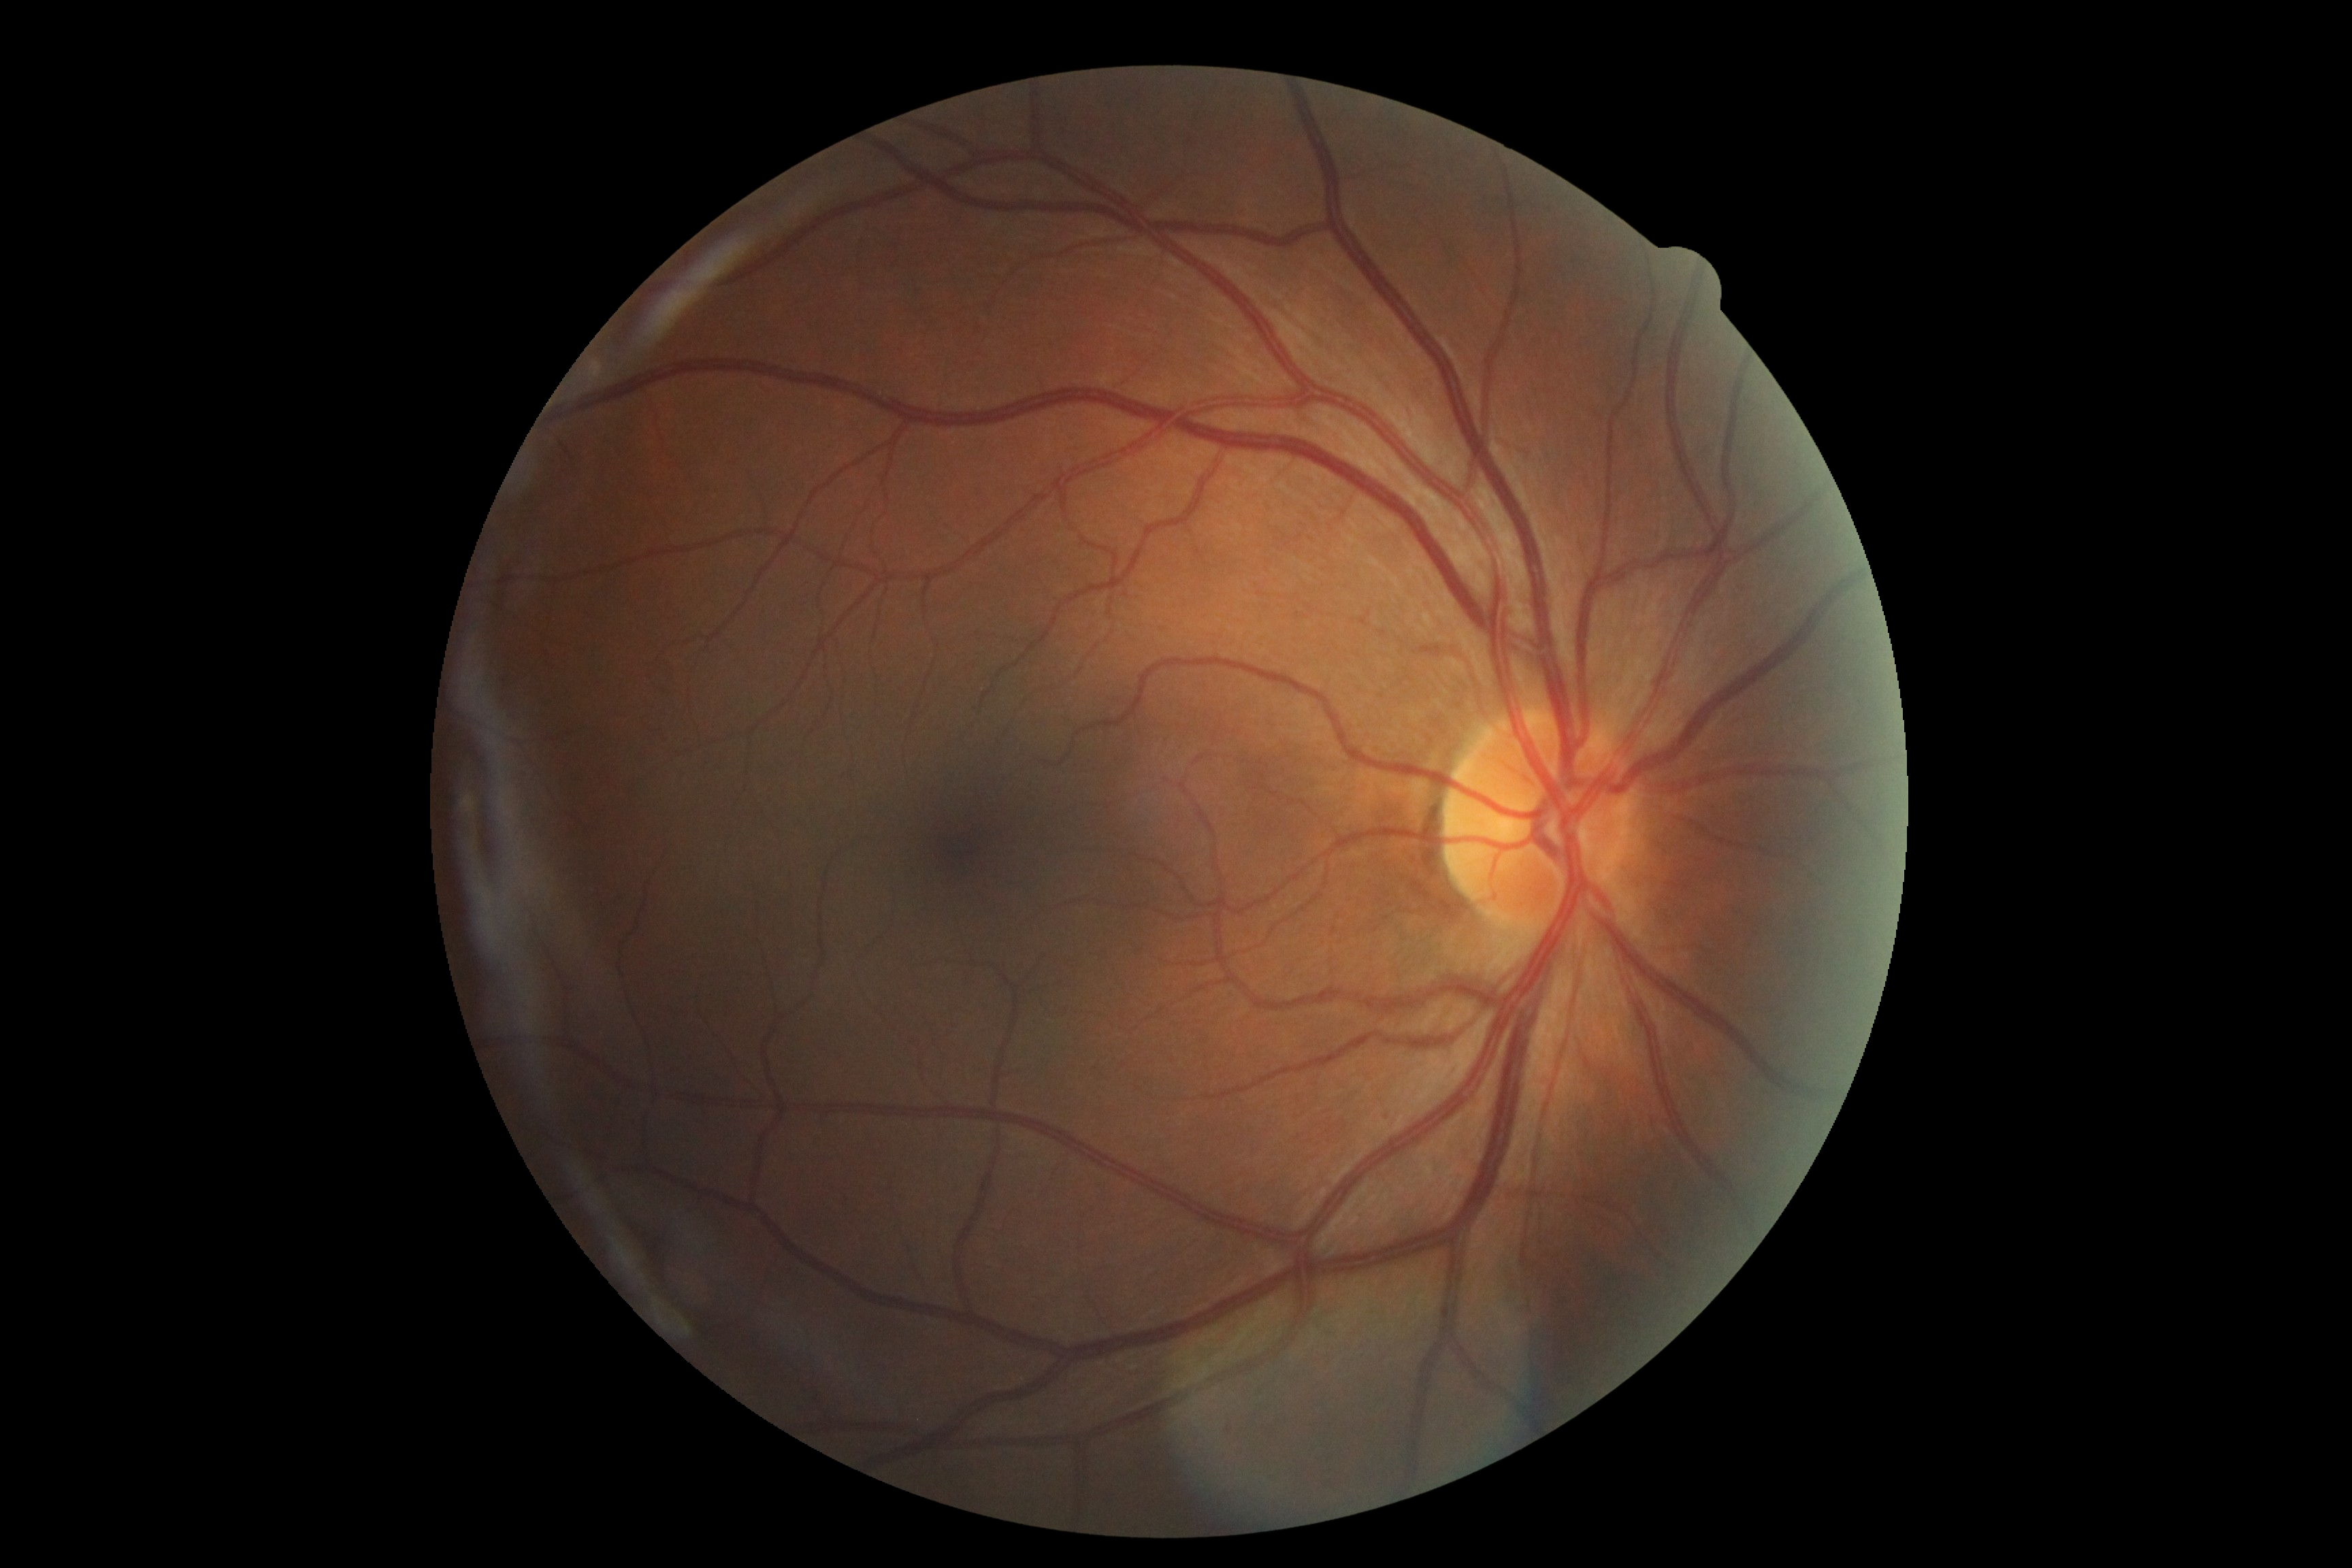 Annotations:
– retinopathy — 0